Diabetic retinopathy graded by the modified Davis classification
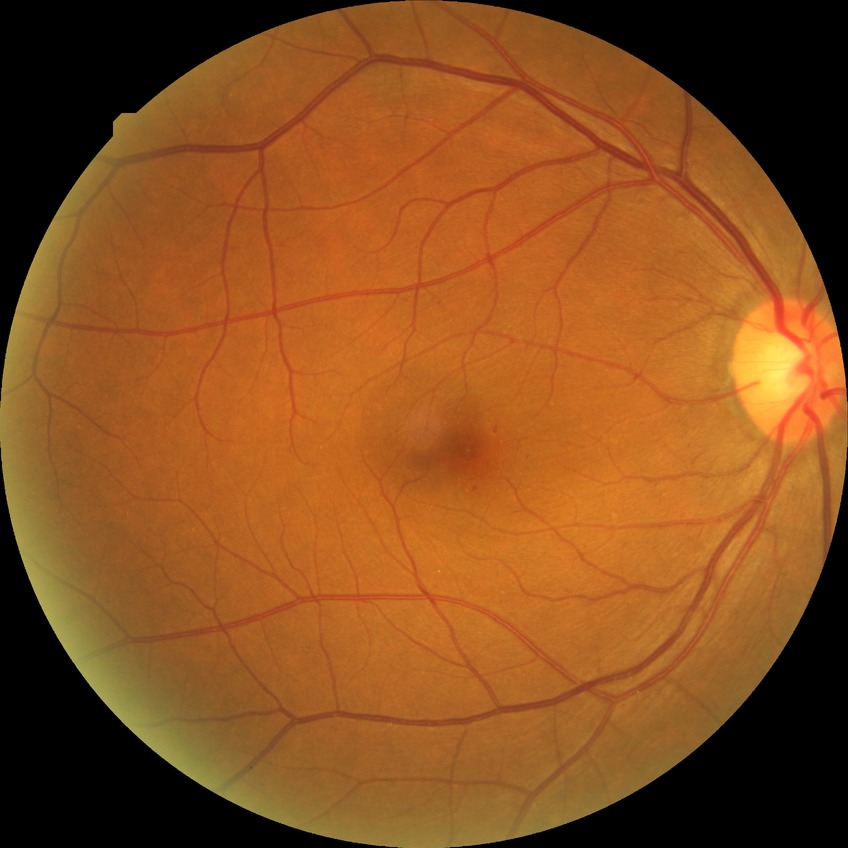 DR class: non-proliferative diabetic retinopathy, Davis stage: SDR.